FOV: 45 degrees:
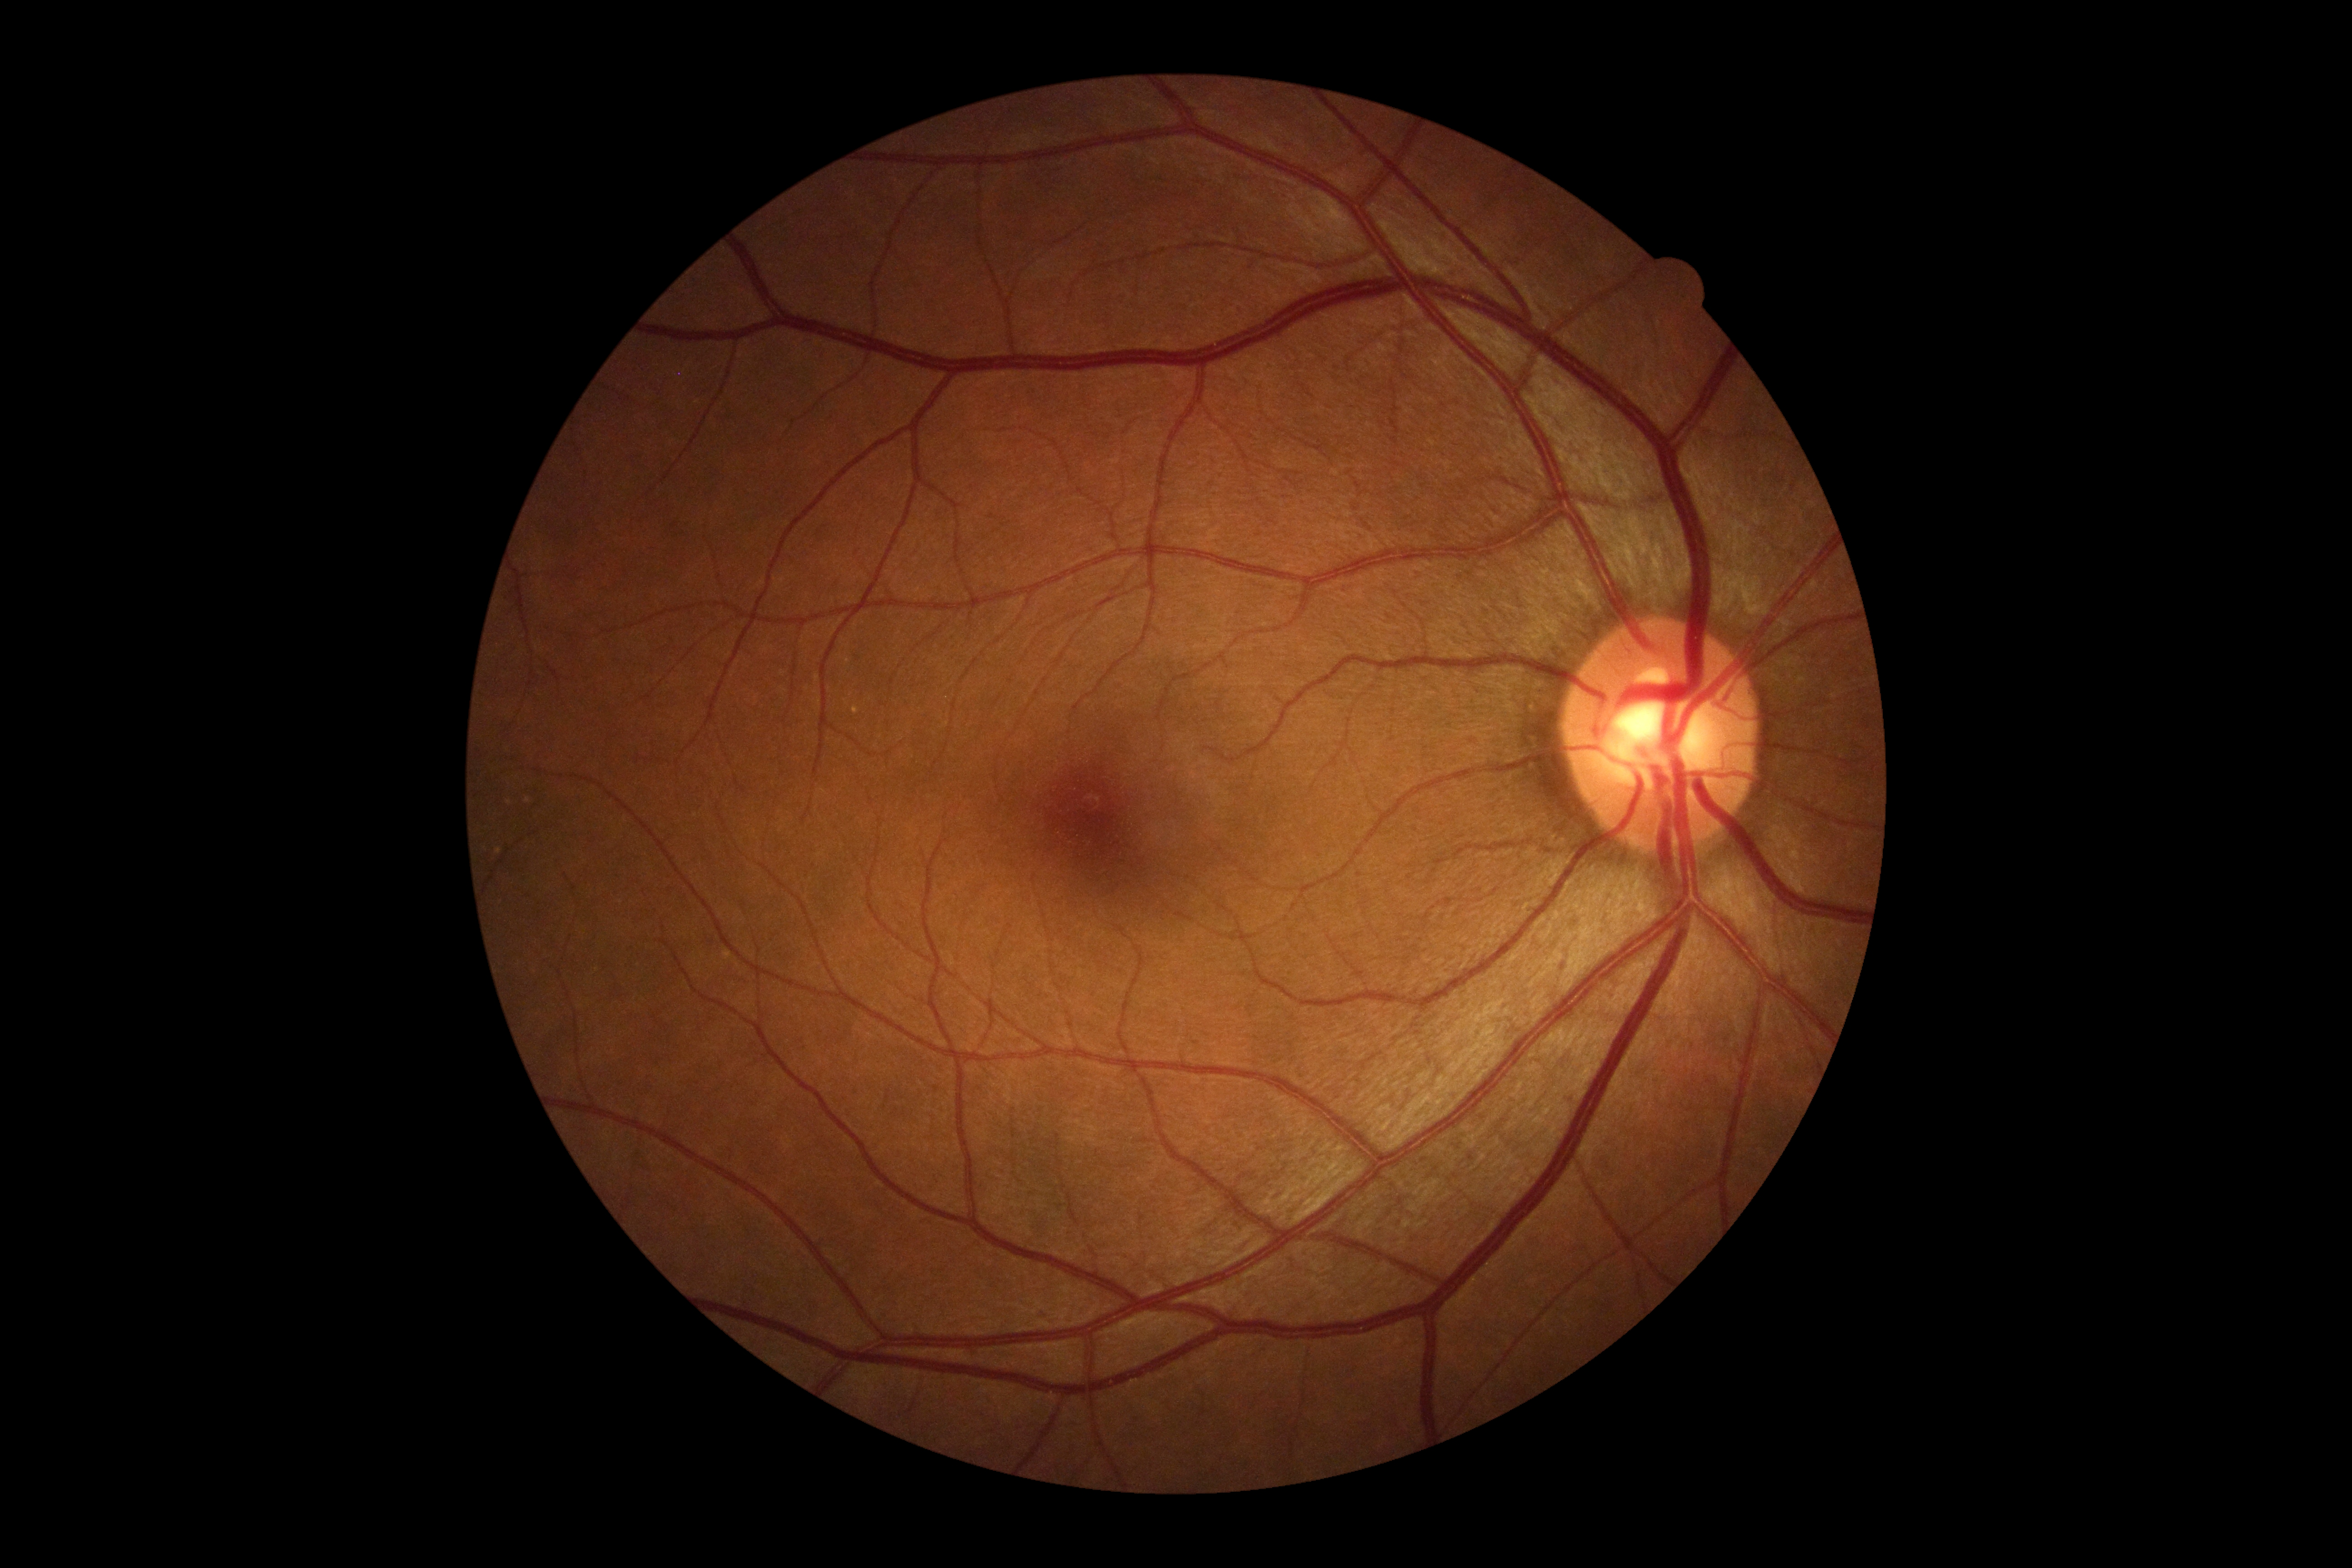 DR grade is 0/4.